848x848px; acquired with a NIDEK AFC-230; CFP; 45° FOV
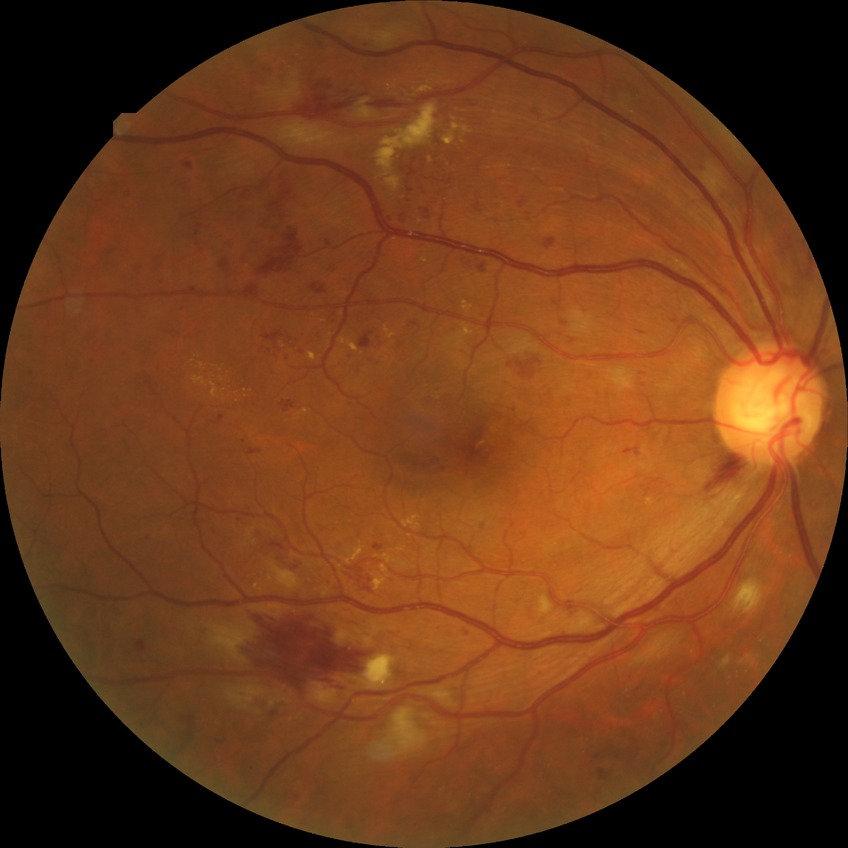
  davis_grade: PPDR (pre-proliferative diabetic retinopathy)